Phoenix ICON wide-field infant fundus image; 1240x1240px.
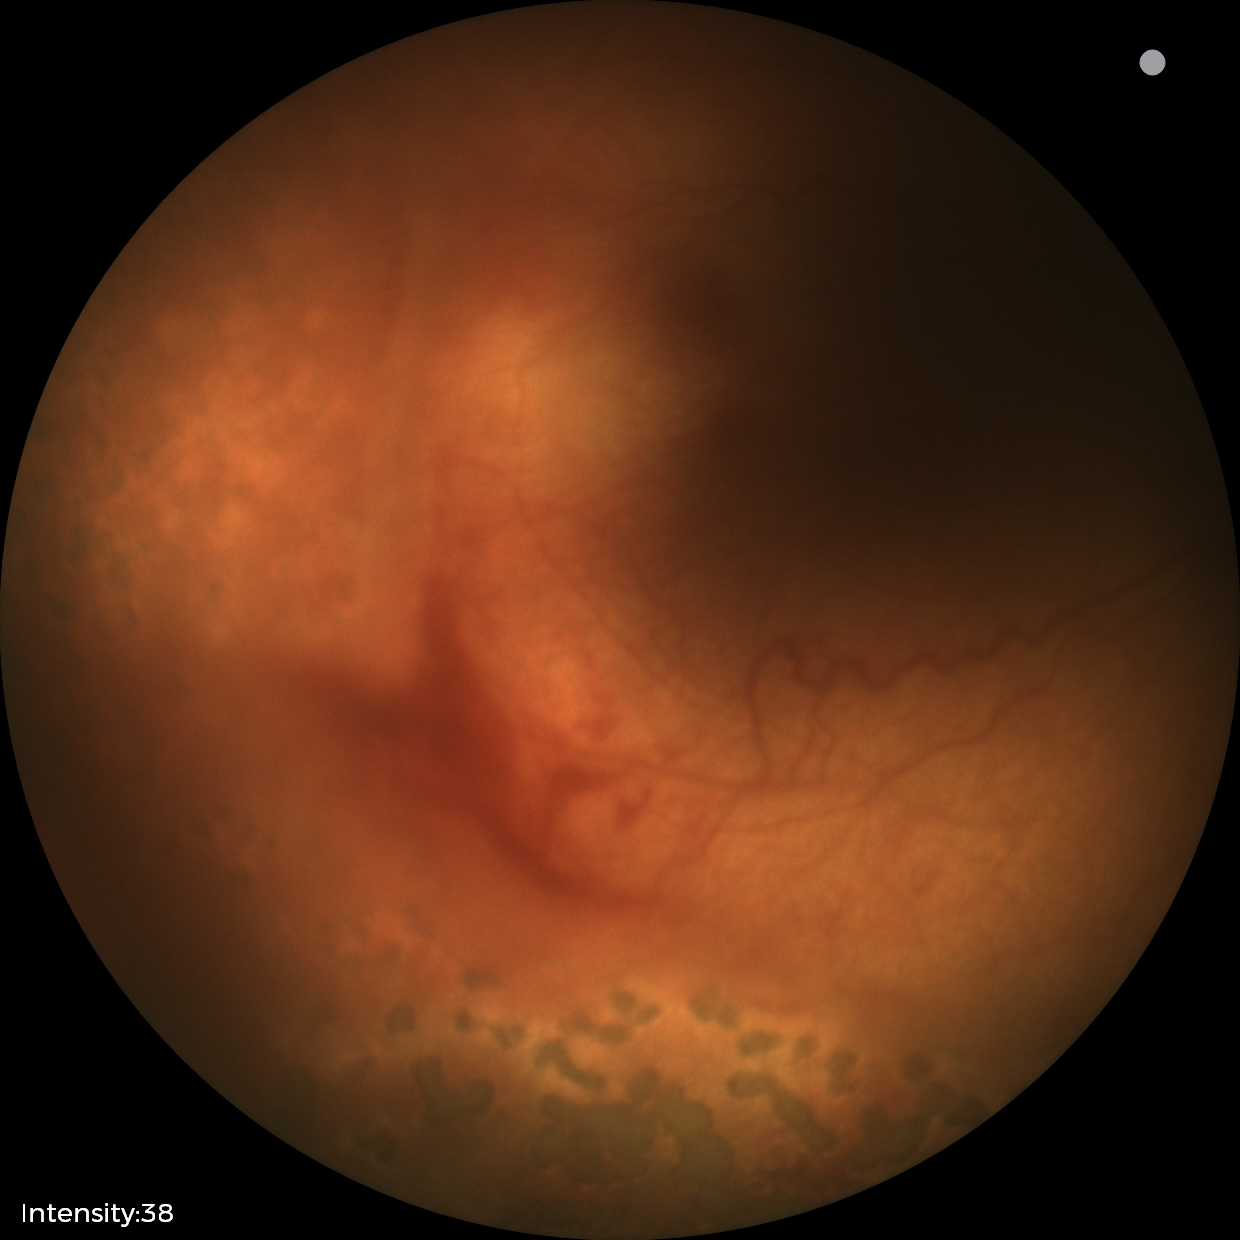 Screening diagnosis: status post ROP — retinal appearance after treated retinopathy of prematurity, plus form: absent.